Pediatric retinal photograph (wide-field): 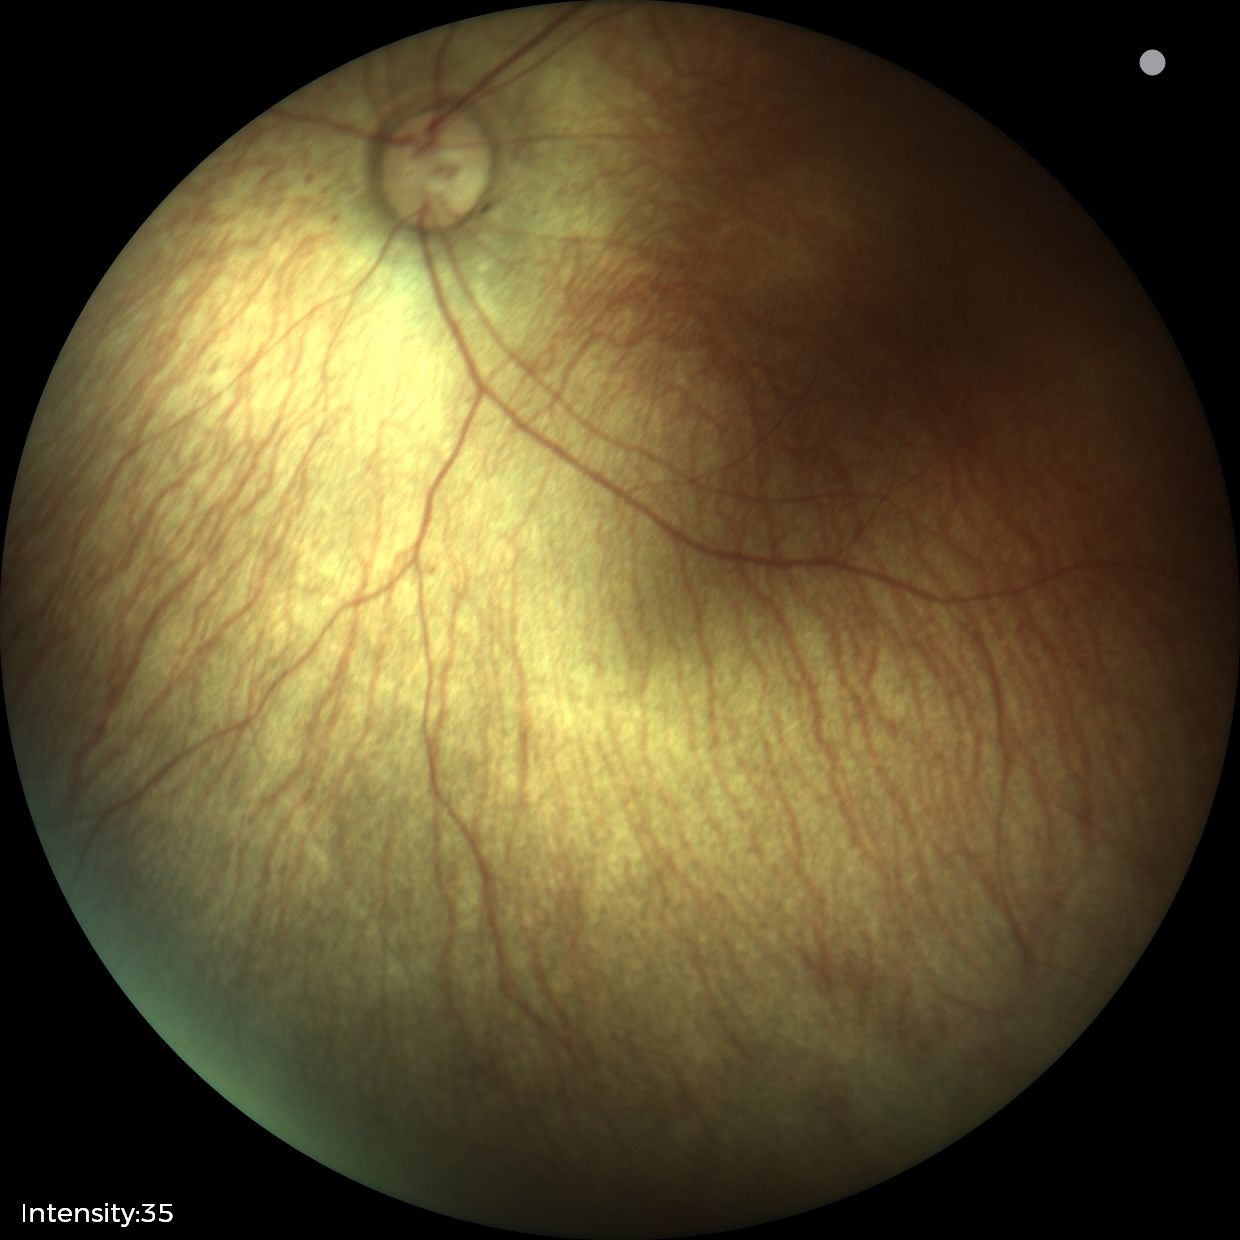 Assessment: no abnormal retinal findings.